Image size 2102x1736; fundus photo:
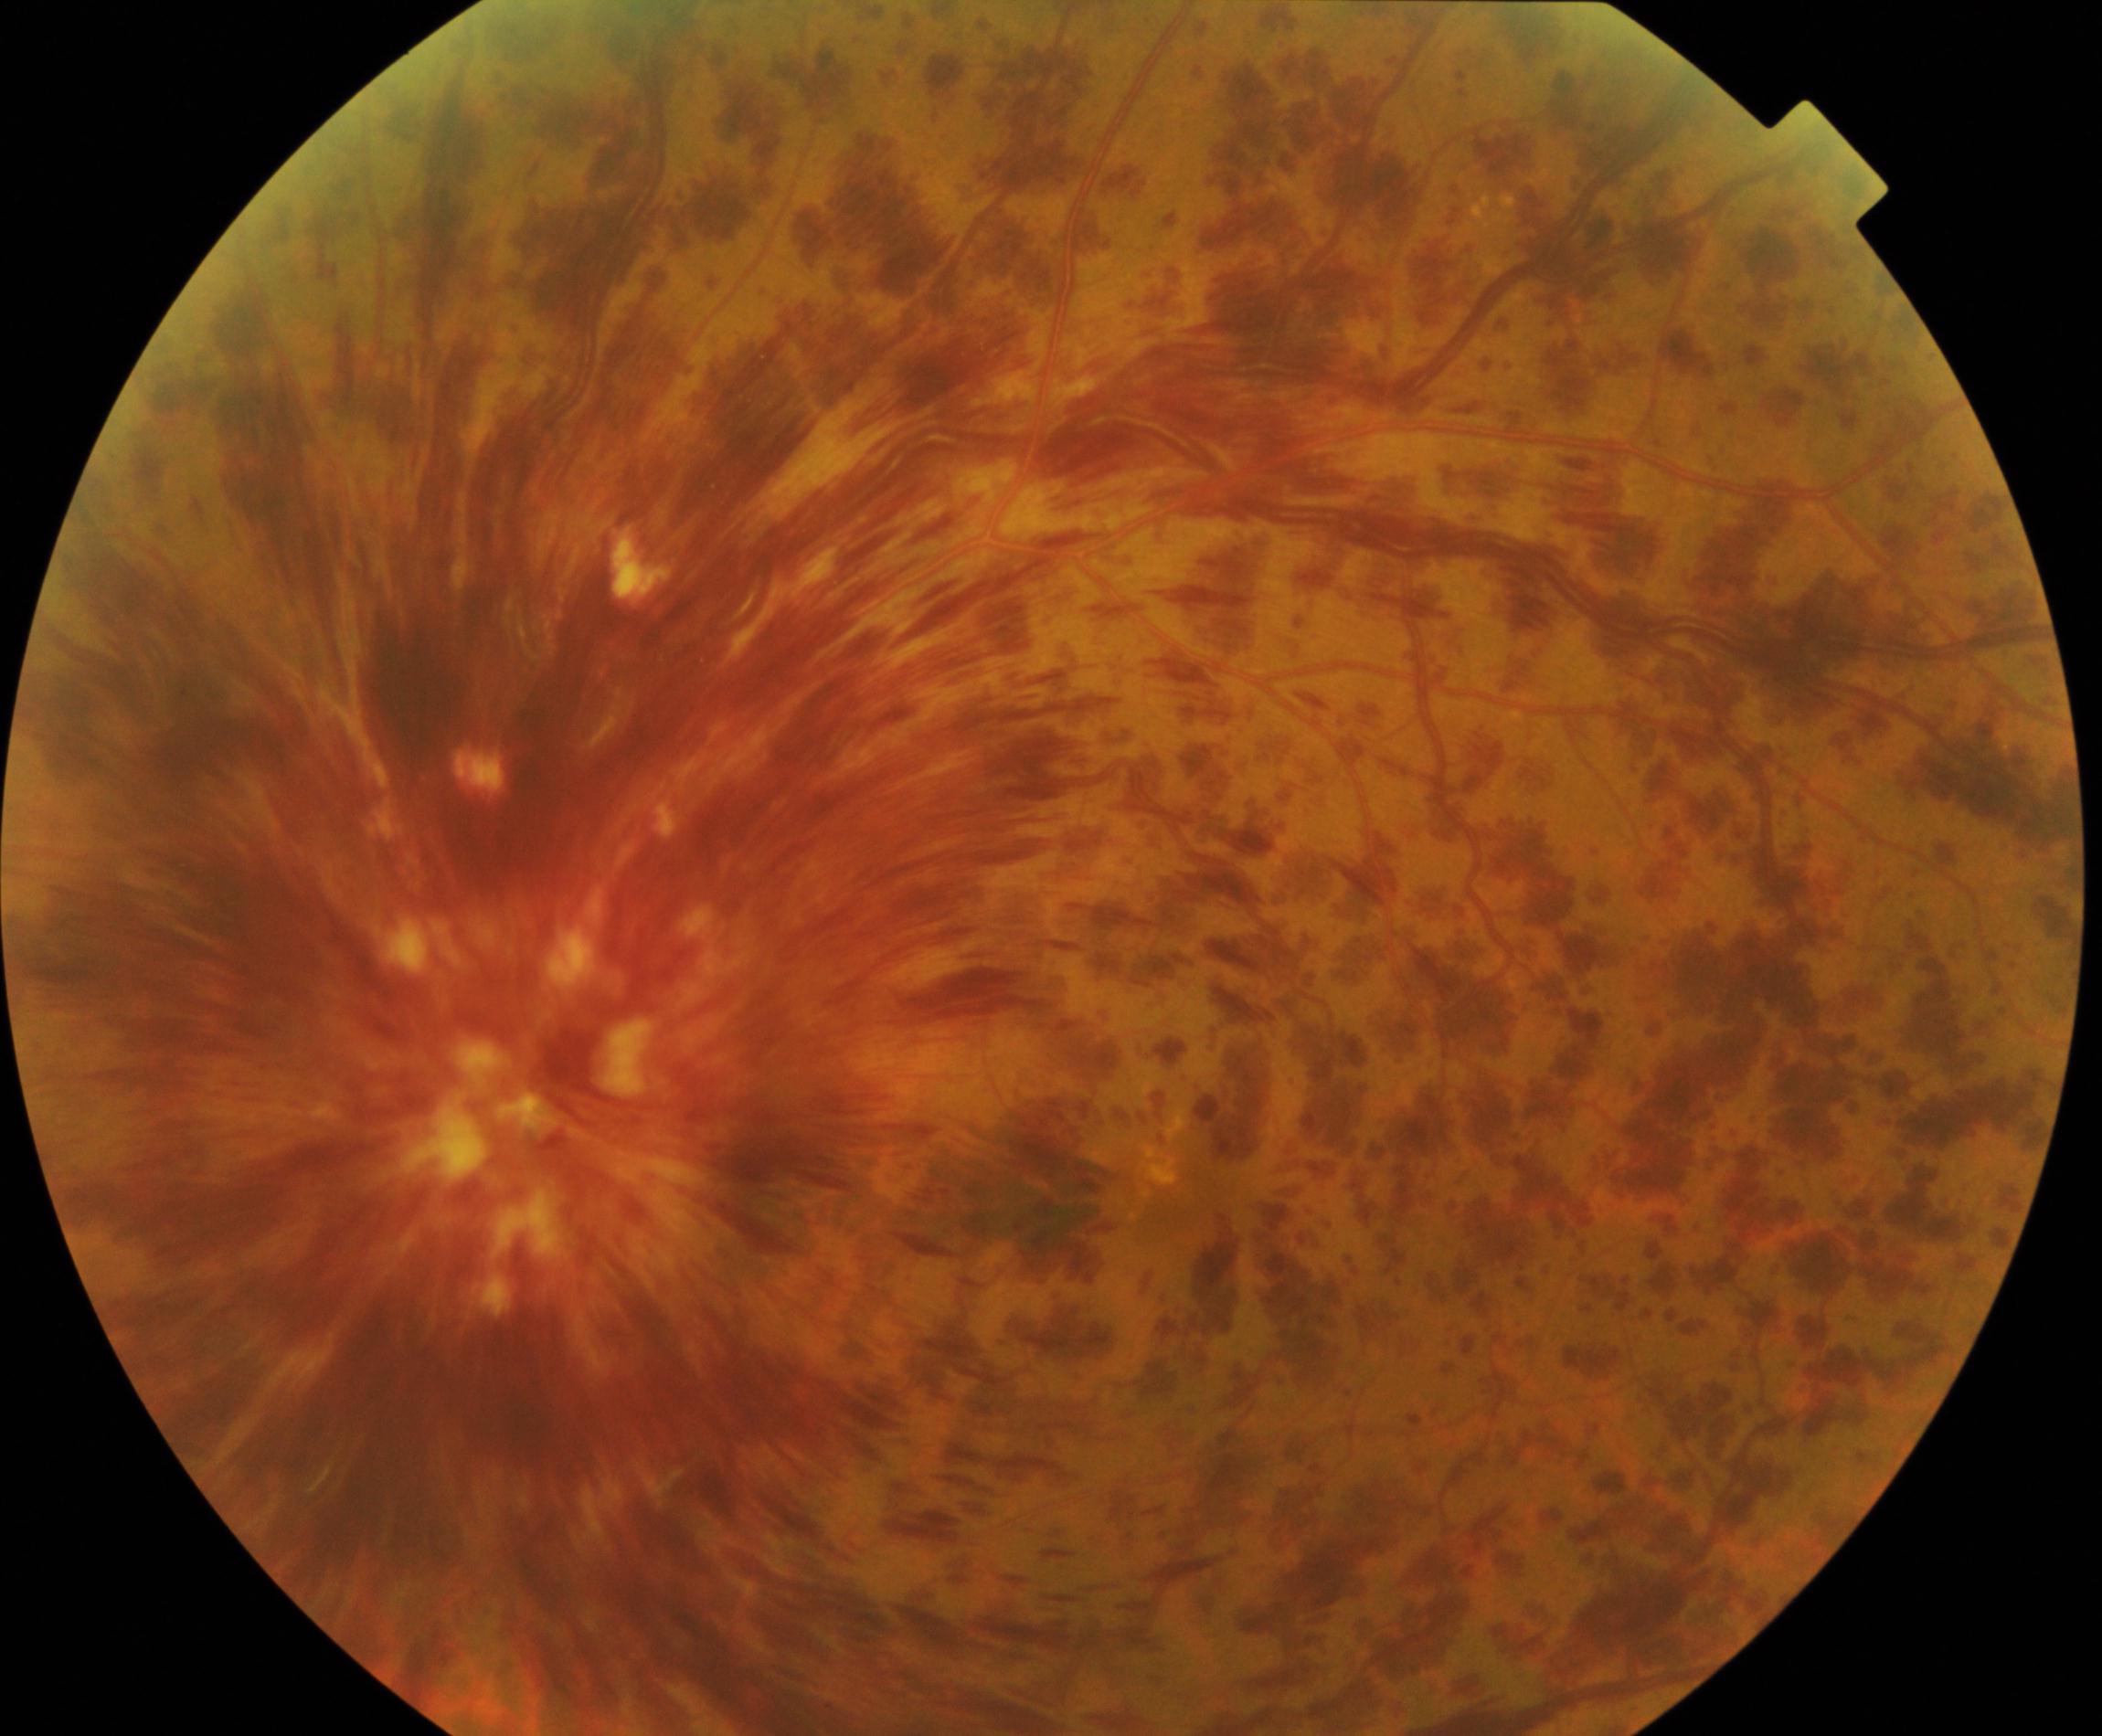
Primary finding: central retinal vein occlusion (CRVO).